Wide-field fundus photograph from neonatal ROP screening. Captured with the Phoenix ICON (100° field of view) — 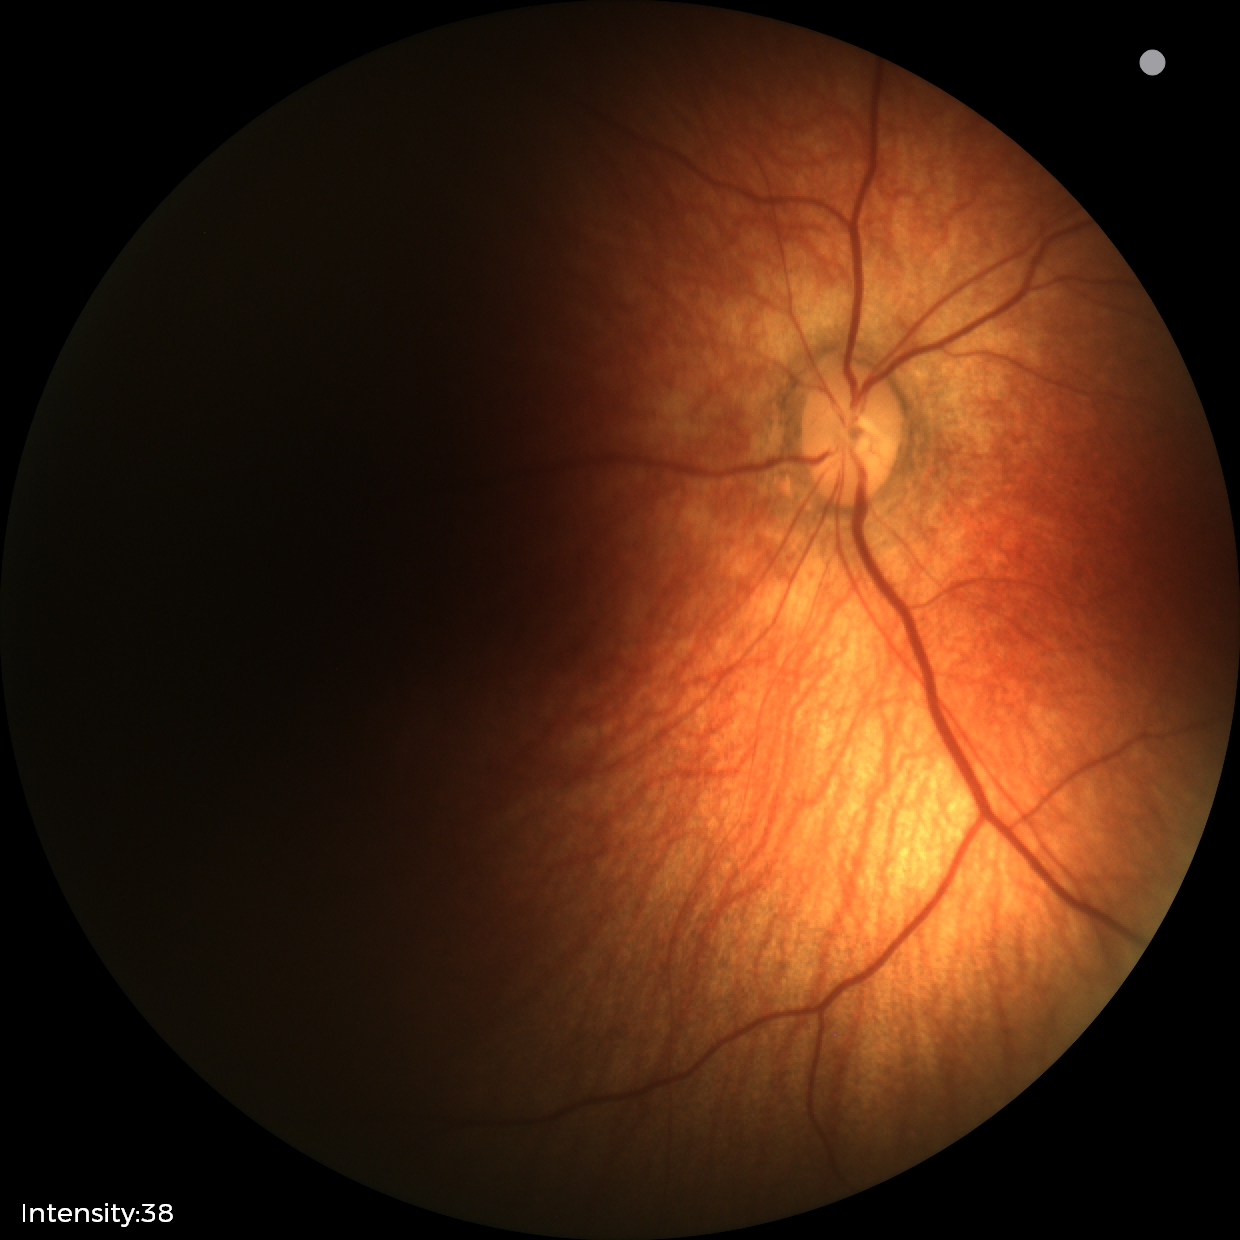 Screening: physiological finding.